ONH-centered crop from a color fundus image.
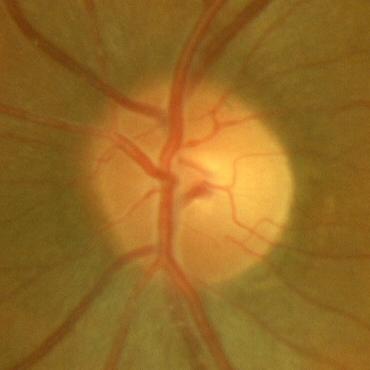
Demonstrates no glaucomatous findings.